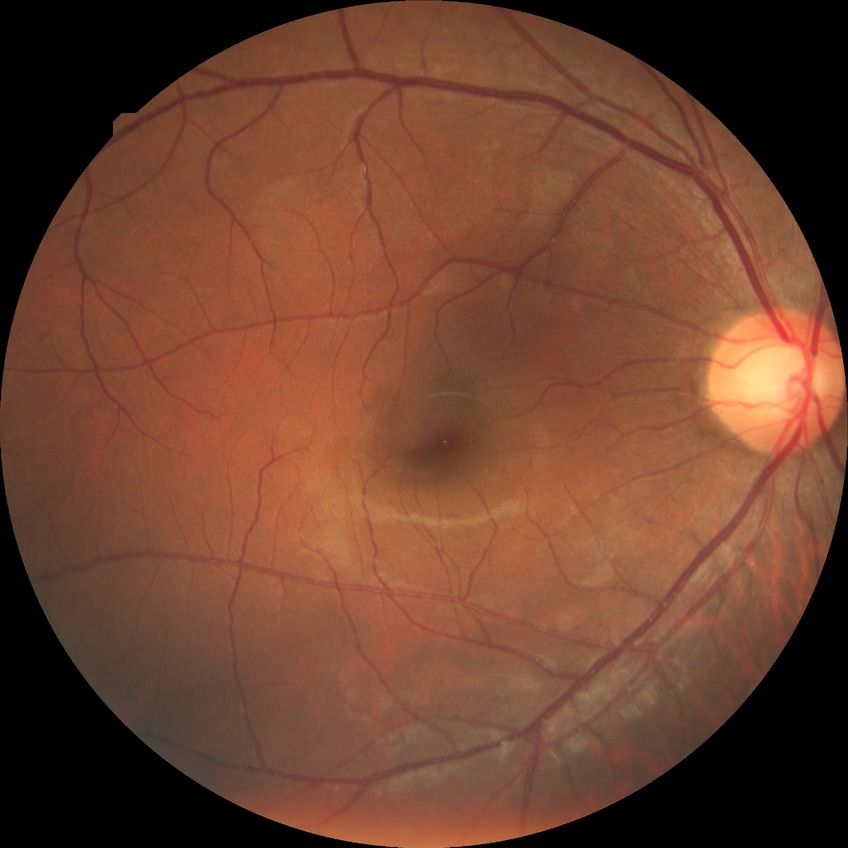 {"davis_grade": "no diabetic retinopathy (NDR)"}